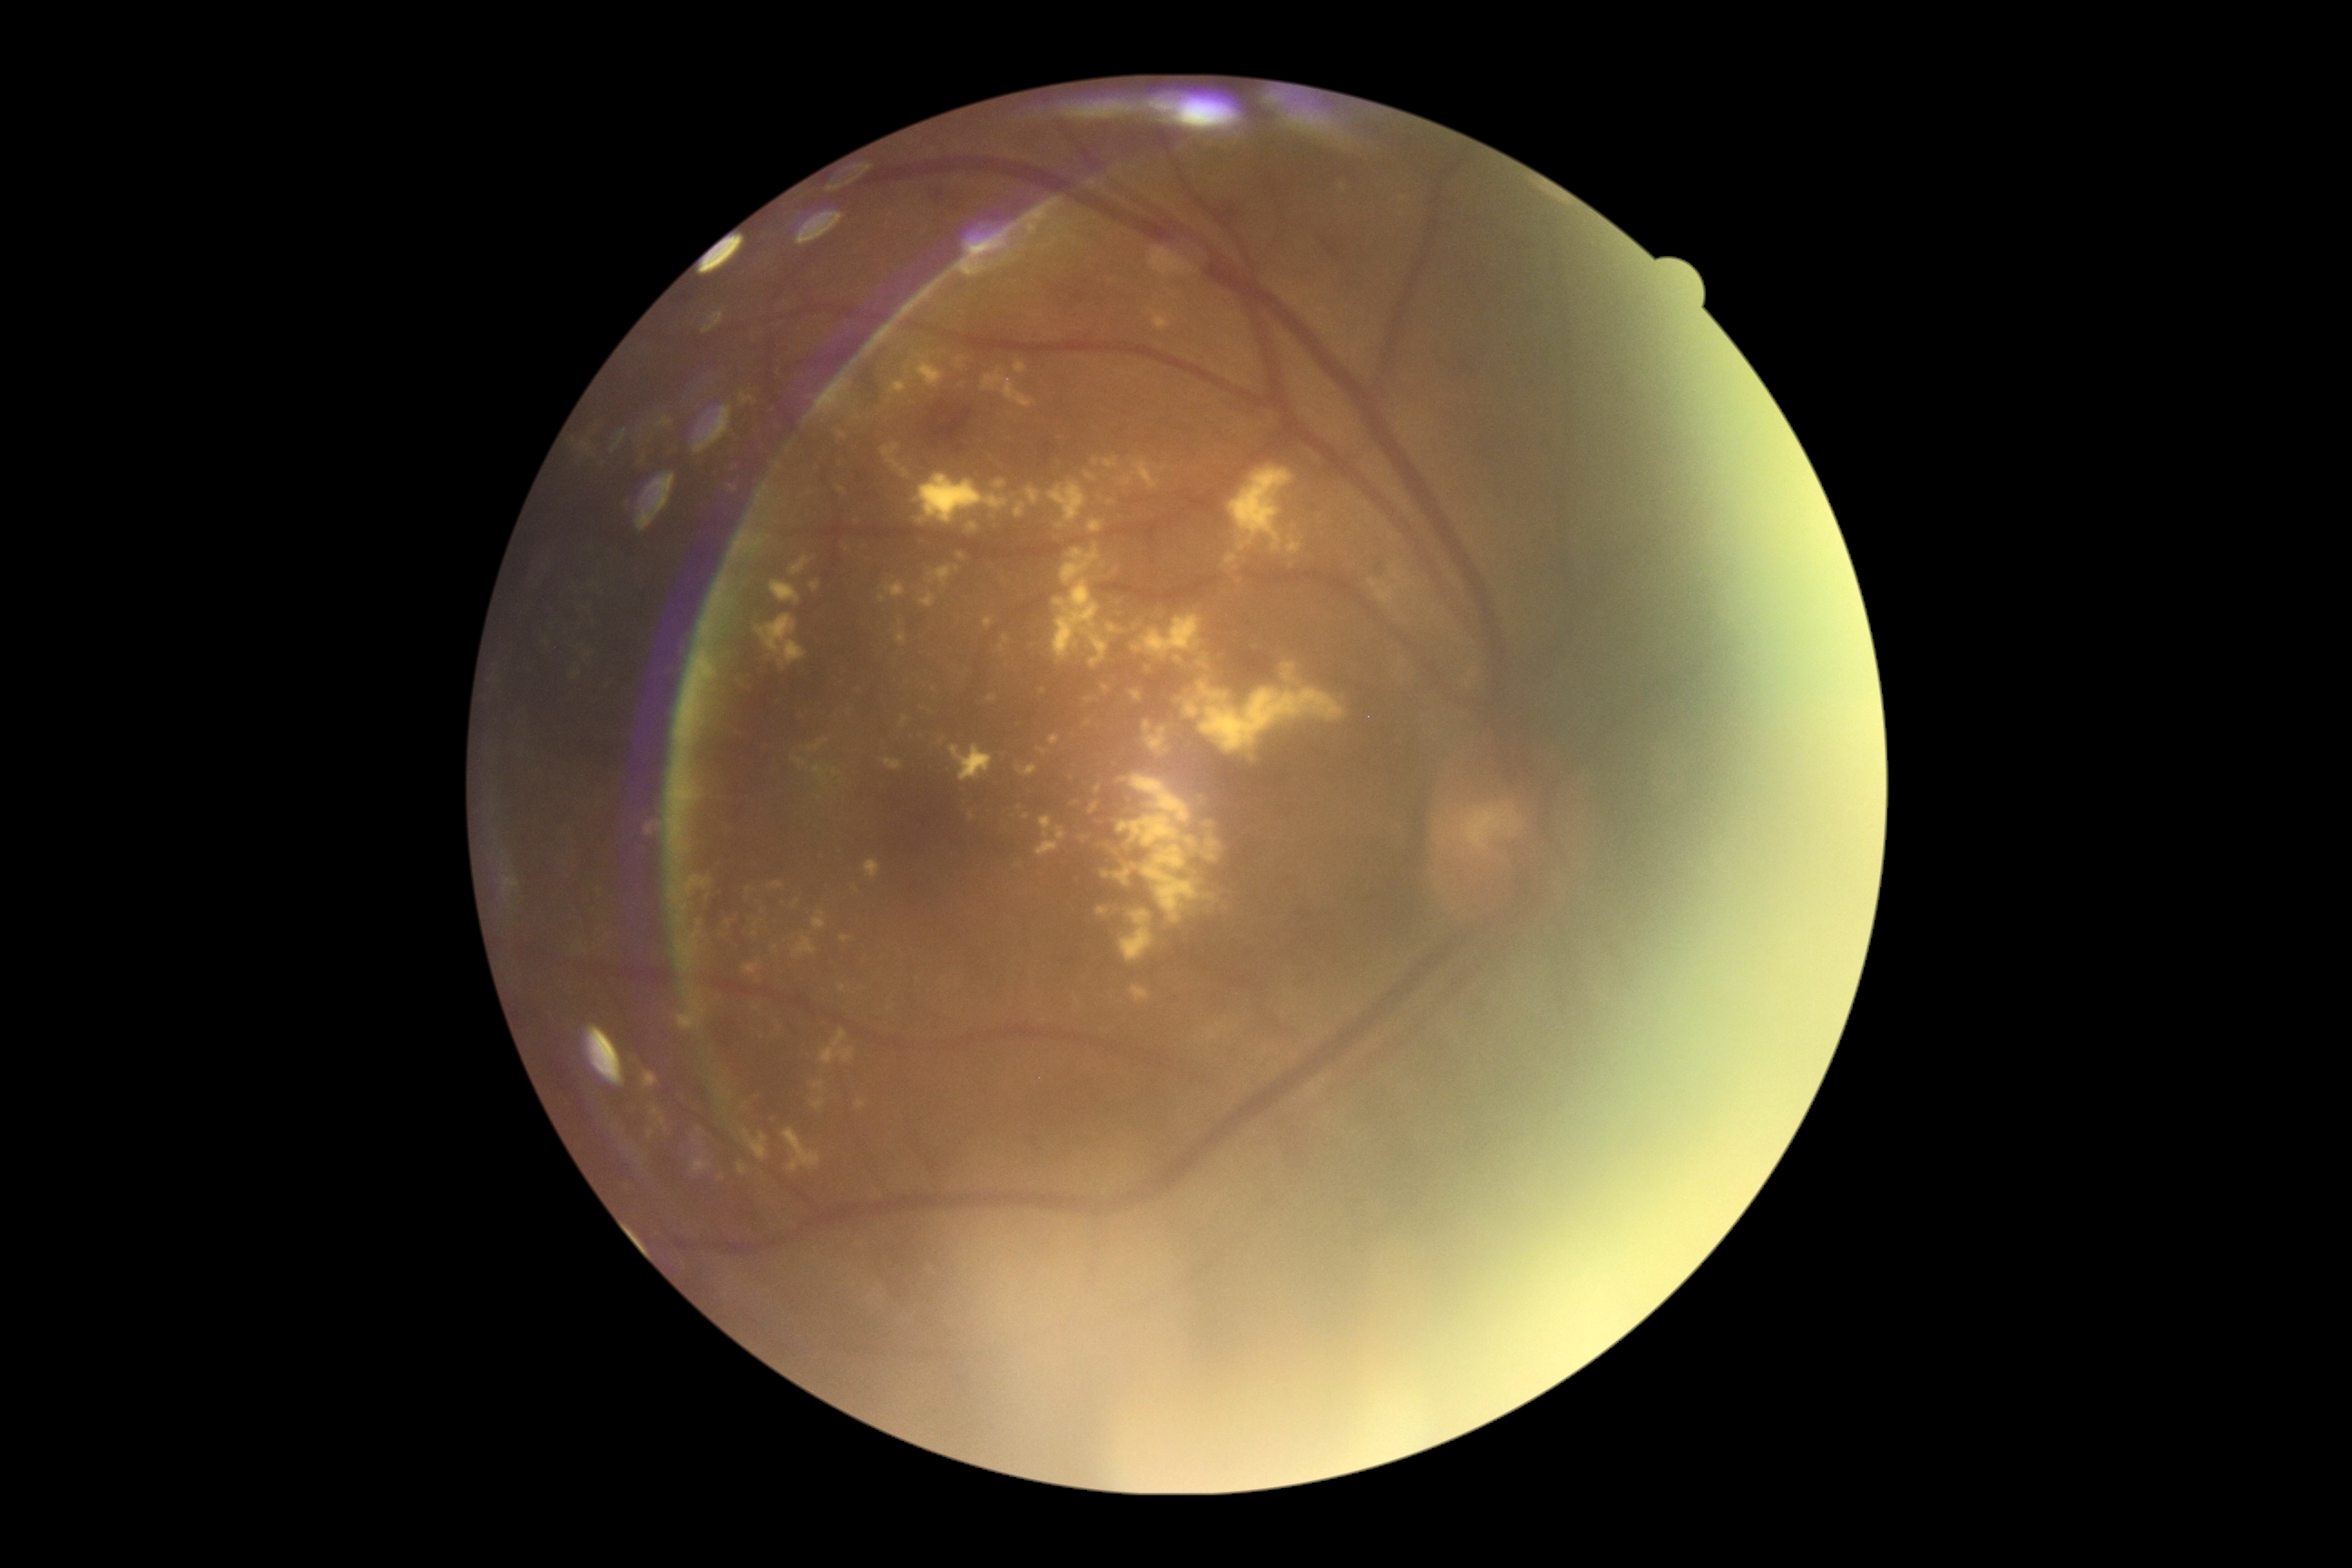

diabetic retinopathy (DR): 2/4.